Phoenix ICON wide-field infant fundus image.
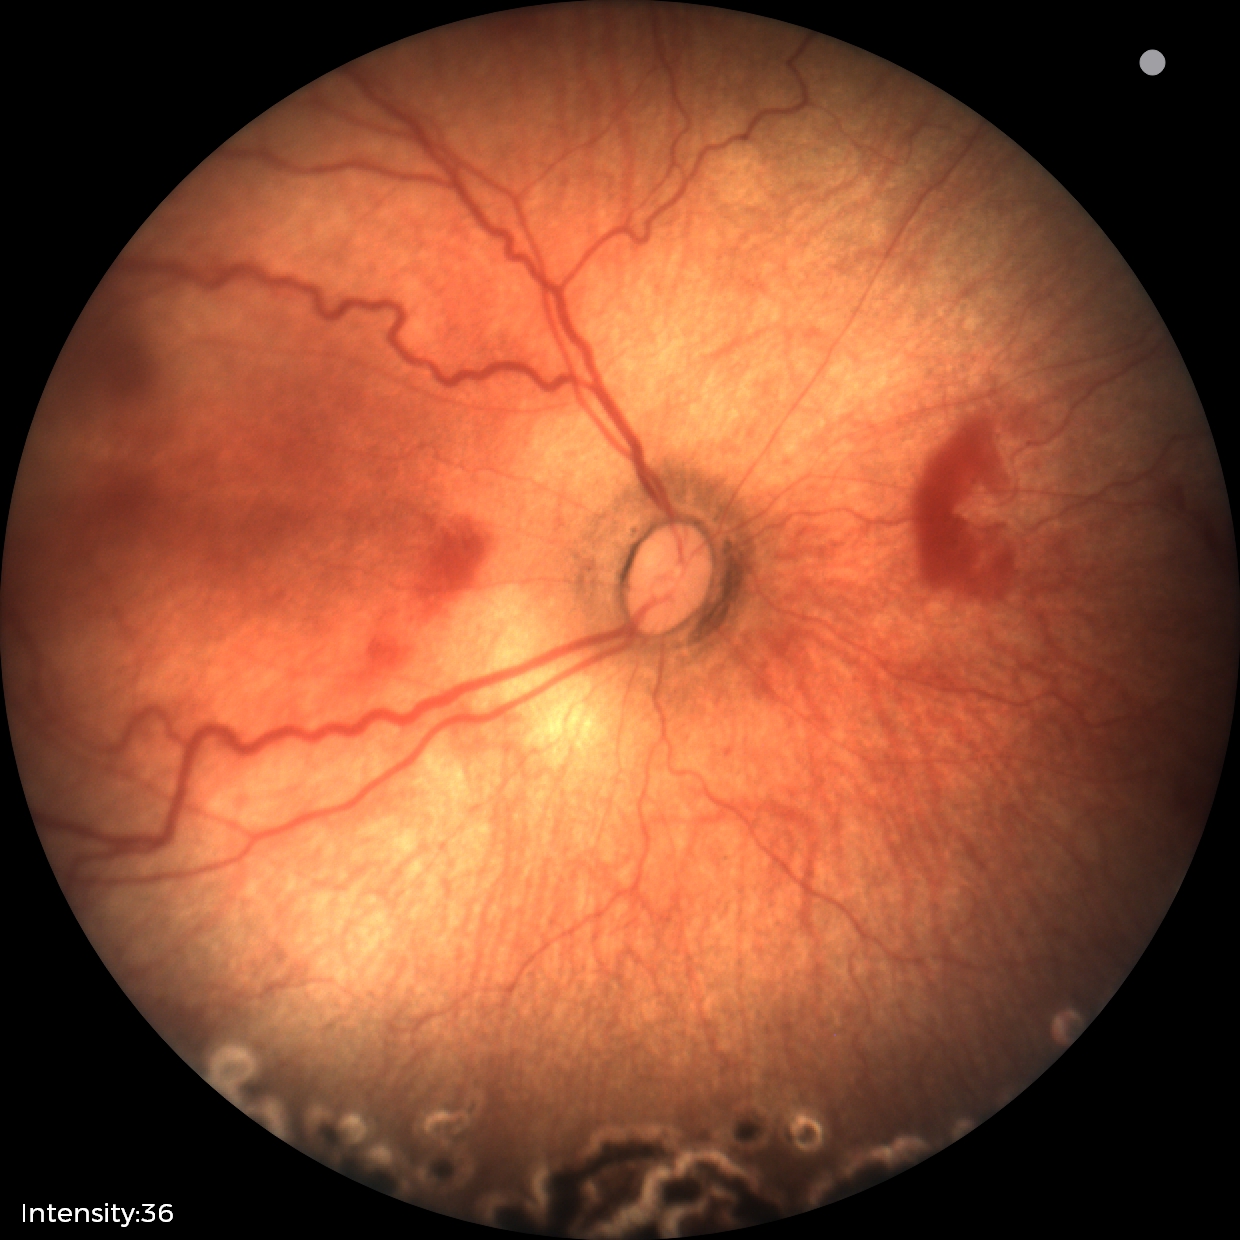

Plus disease = absent; screening diagnosis = status post retinopathy of prematurity (ROP) — retinal appearance after treated retinopathy of prematurity.